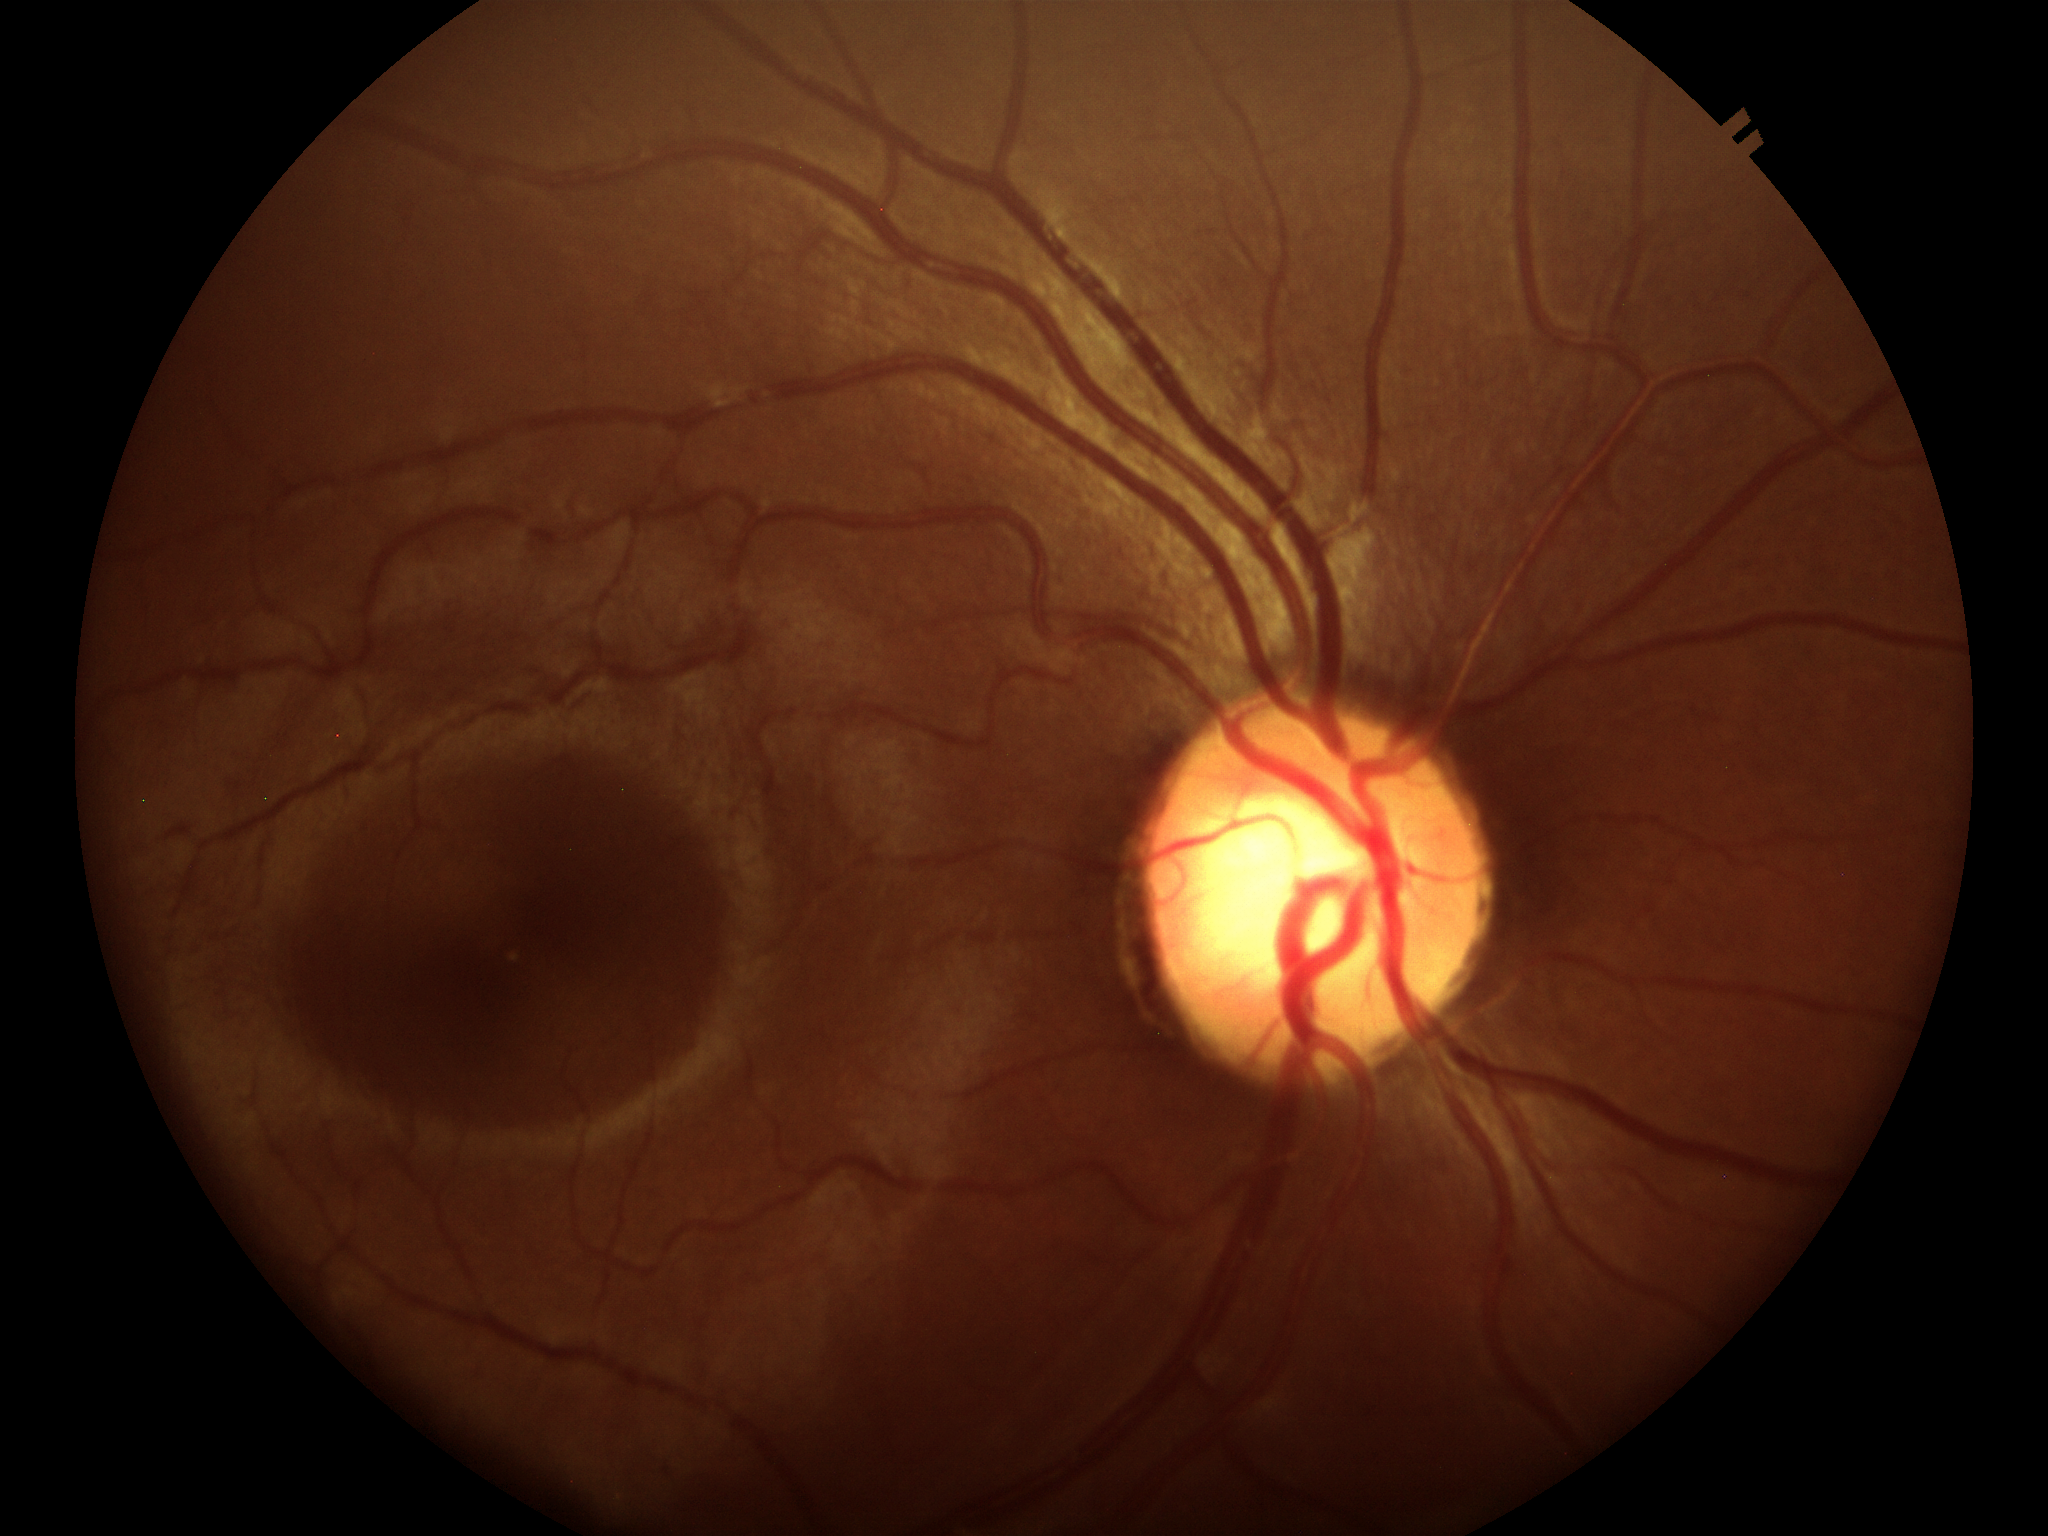
Optic disc analysis:
- Glaucoma evaluation — negative (unanimous normal call)
- horizontal C/D ratio — 0.59
- vertical cup-to-disc ratio — 0.57